Wide-field fundus image from infant ROP screening; camera: Natus RetCam Envision (130° FOV): 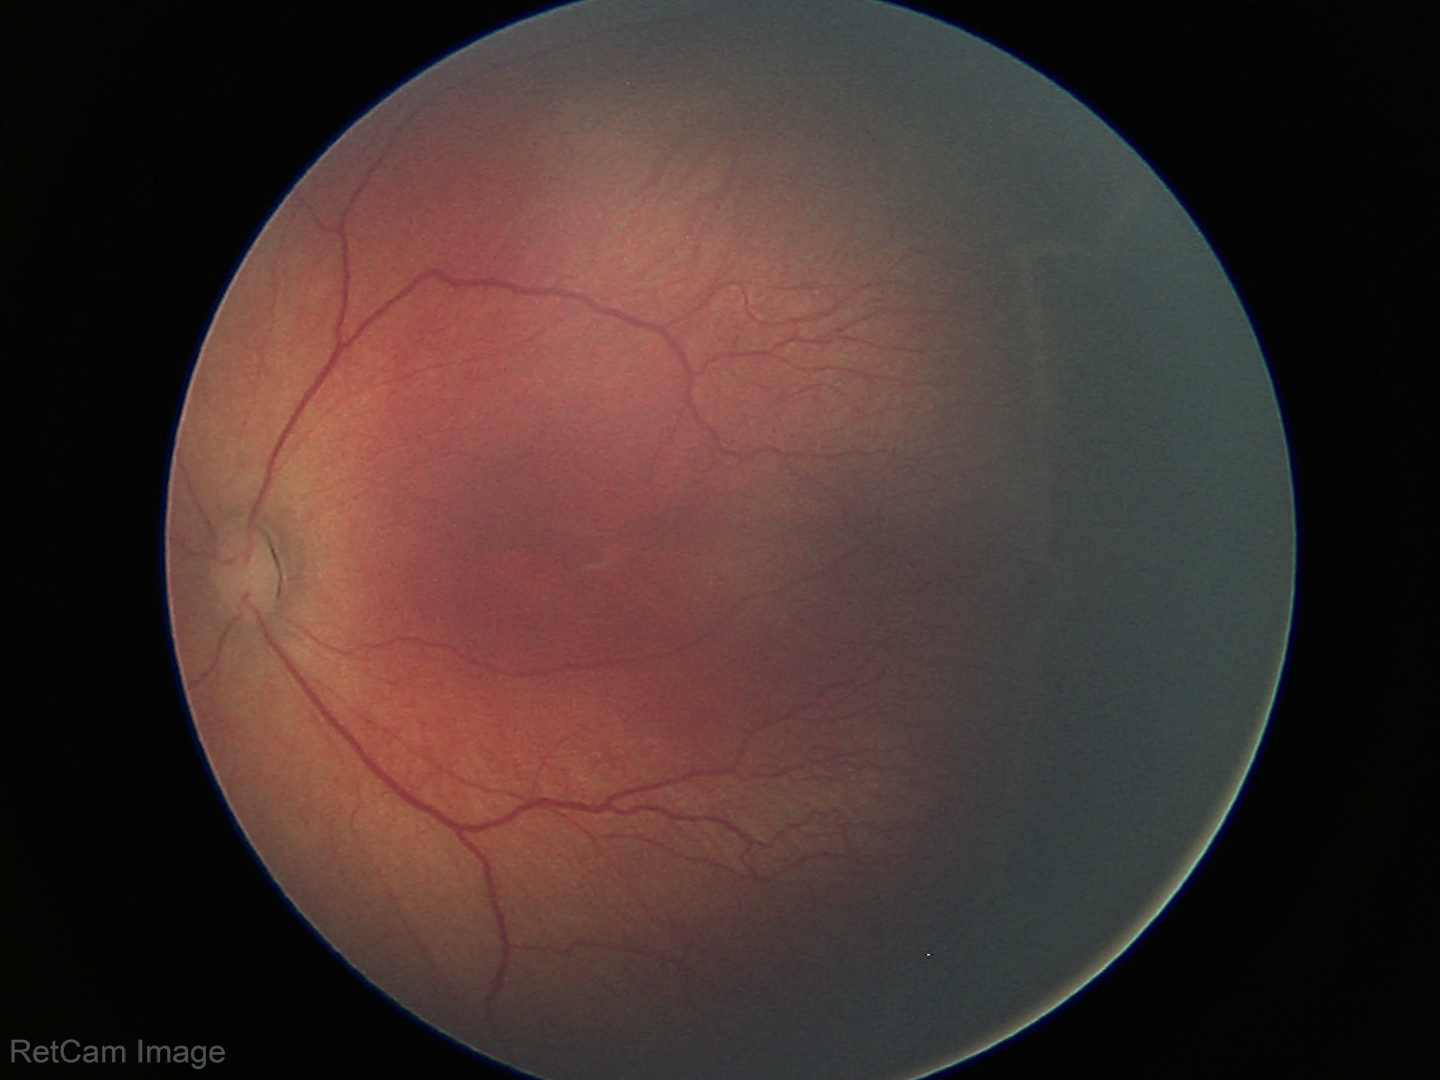 Assessment: ROP stage 2 | no plus disease.